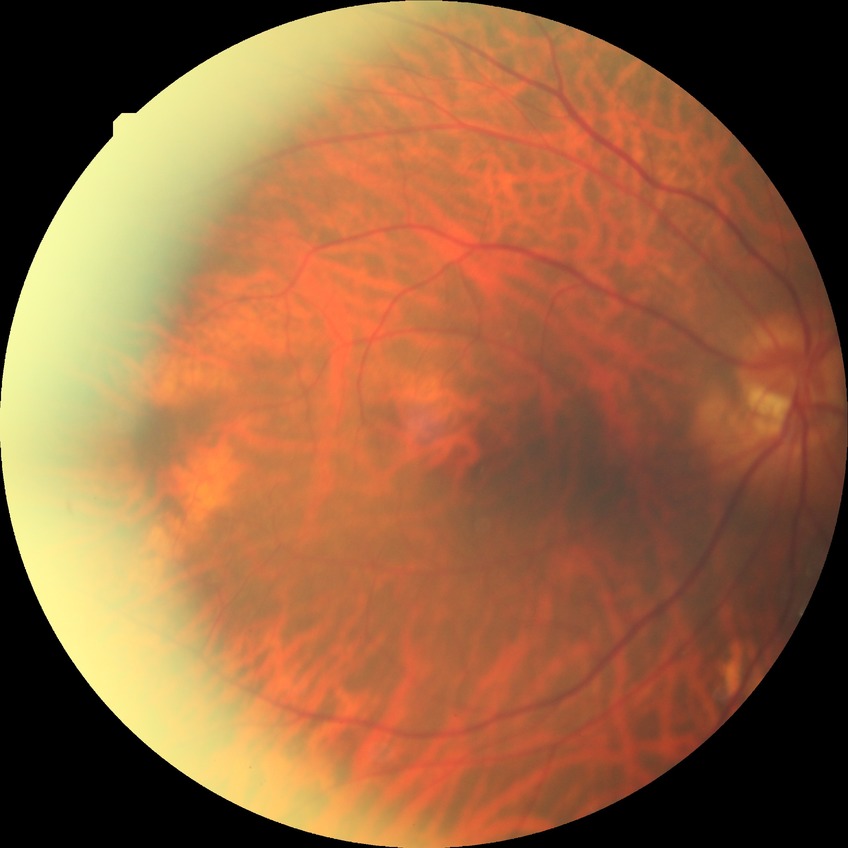

diabetic retinopathy stage = no diabetic retinopathy.